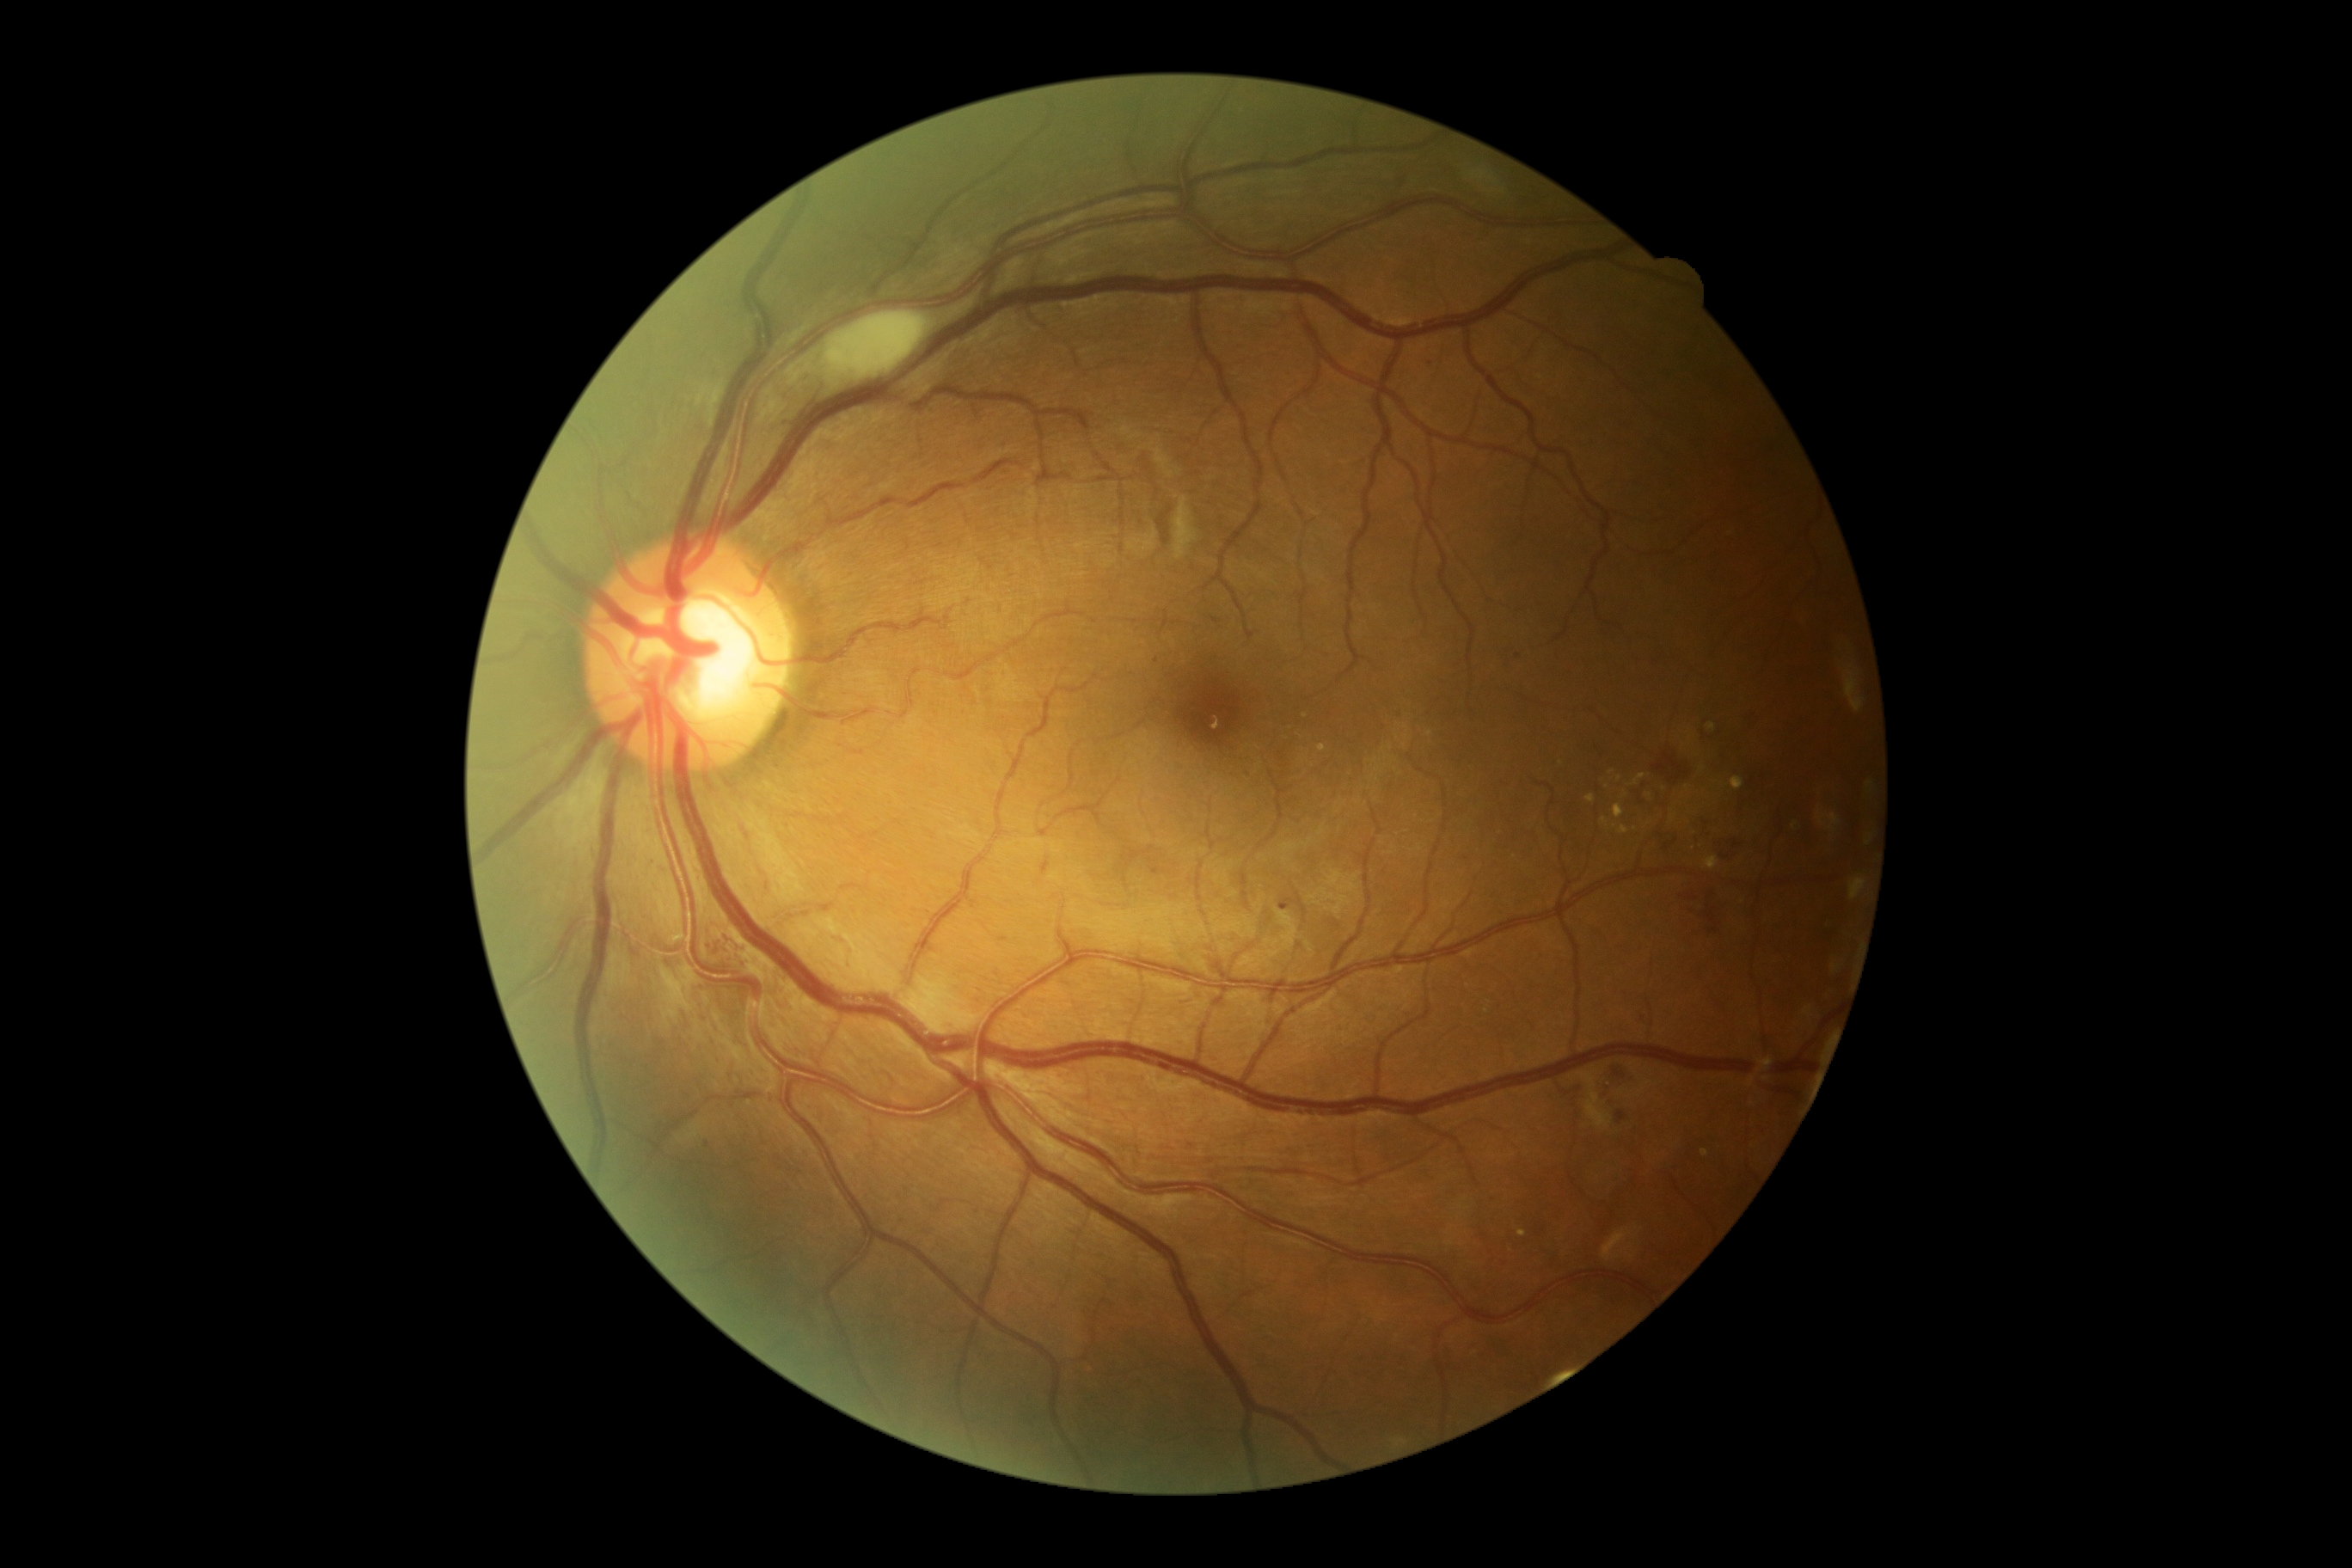

Diabetic retinopathy (DR) is 2 — more than just microaneurysms but less than severe NPDR
A subset of detected lesions:
soft exudates (SEs): x1=1471 y1=171 x2=1498 y2=185; x1=824 y1=312 x2=929 y2=379; x1=1579 y1=1072 x2=1614 y2=1129
Small SEs near (1493, 191); (1503, 191)
hard exudates (EXs) (more not shown): x1=1708 y1=723 x2=1717 y2=732; x1=1517 y1=1230 x2=1528 y2=1237; x1=1586 y1=793 x2=1595 y2=802; x1=1318 y1=744 x2=1326 y2=752; x1=1614 y1=804 x2=1624 y2=819; x1=1705 y1=857 x2=1718 y2=869; x1=1670 y1=814 x2=1677 y2=823; x1=1732 y1=778 x2=1744 y2=790; x1=1632 y1=773 x2=1646 y2=785; x1=1602 y1=818 x2=1608 y2=830; x1=1619 y1=826 x2=1629 y2=835
Small EXs near (1619, 778); (1430, 734); (1687, 788); (1606, 786); (1615, 826); (1664, 789); (1612, 773); (1625, 796); (1306, 715)
hemorrhages (HEs): x1=1615 y1=1069 x2=1624 y2=1075; x1=1662 y1=828 x2=1682 y2=852; x1=1658 y1=747 x2=1696 y2=792; x1=1722 y1=835 x2=1746 y2=859; x1=1777 y1=1087 x2=1801 y2=1098; x1=1705 y1=910 x2=1715 y2=922; x1=1694 y1=814 x2=1710 y2=836; x1=1617 y1=1112 x2=1626 y2=1124
Small HEs near (1713, 816); (1715, 930)
microaneurysms (MAs) (more not shown): x1=737 y1=948 x2=745 y2=955; x1=1151 y1=867 x2=1167 y2=876; x1=1399 y1=171 x2=1414 y2=190; x1=723 y1=936 x2=732 y2=945; x1=1280 y1=897 x2=1294 y2=909
Small MAs near (718, 953); (1518, 656); (1431, 363); (707, 1144); (1212, 1160); (711, 947); (1156, 661)